848 by 848 pixels; diabetic retinopathy graded by the modified Davis classification.
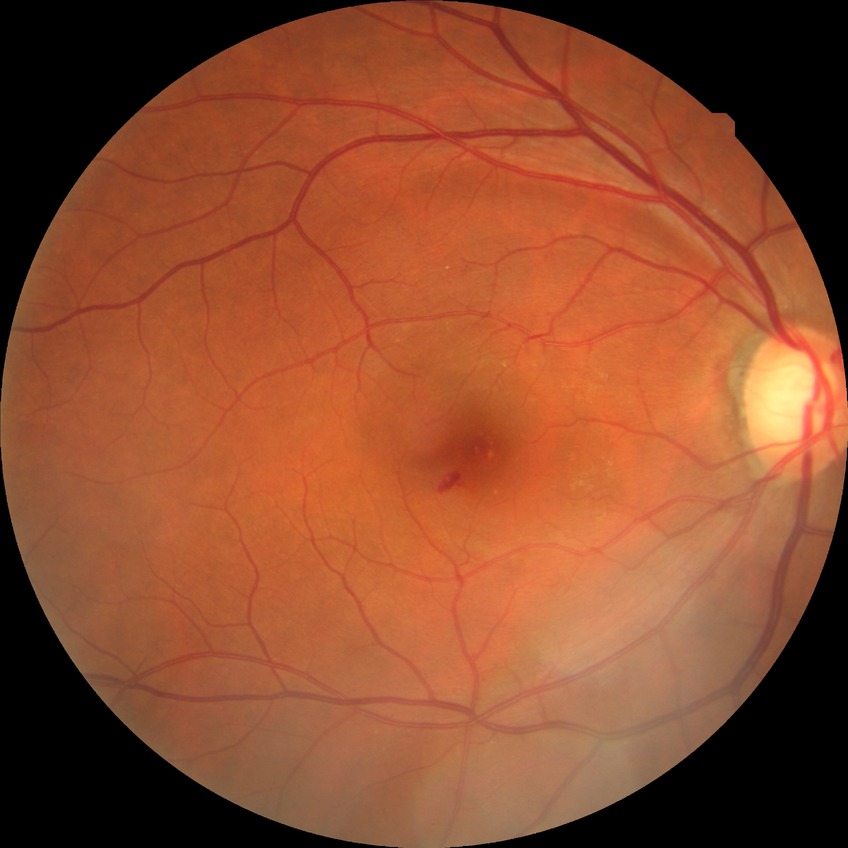 Retinopathy grade is no diabetic retinopathy.